NIDEK AFC-230 · 45° field of view.
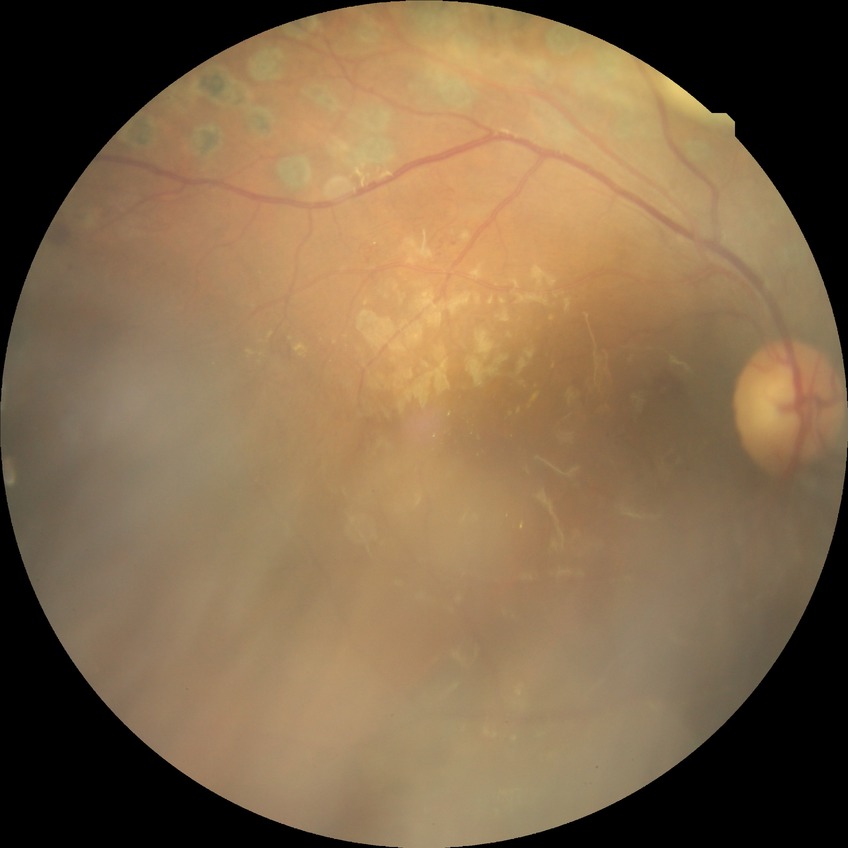
Diabetic retinopathy severity: proliferative diabetic retinopathy.